Optic disc-centered crop from a color fundus photograph, 316 by 316 pixels.
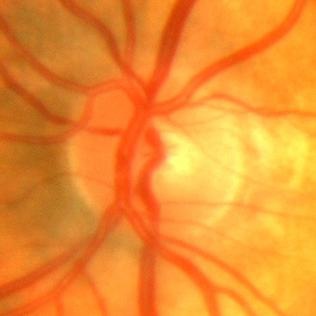 Q: Is there glaucomatous optic neuropathy?
A: No glaucoma.